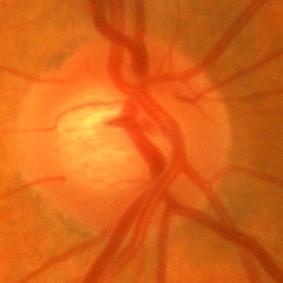 Showing no evidence of glaucoma.